Pediatric retinal photograph (wide-field) · 640 by 480 pixels:
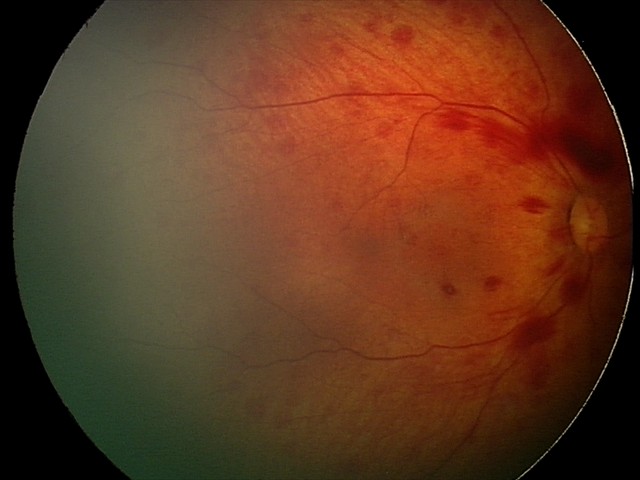

Examination diagnosed as retinal hemorrhages.